CFP — 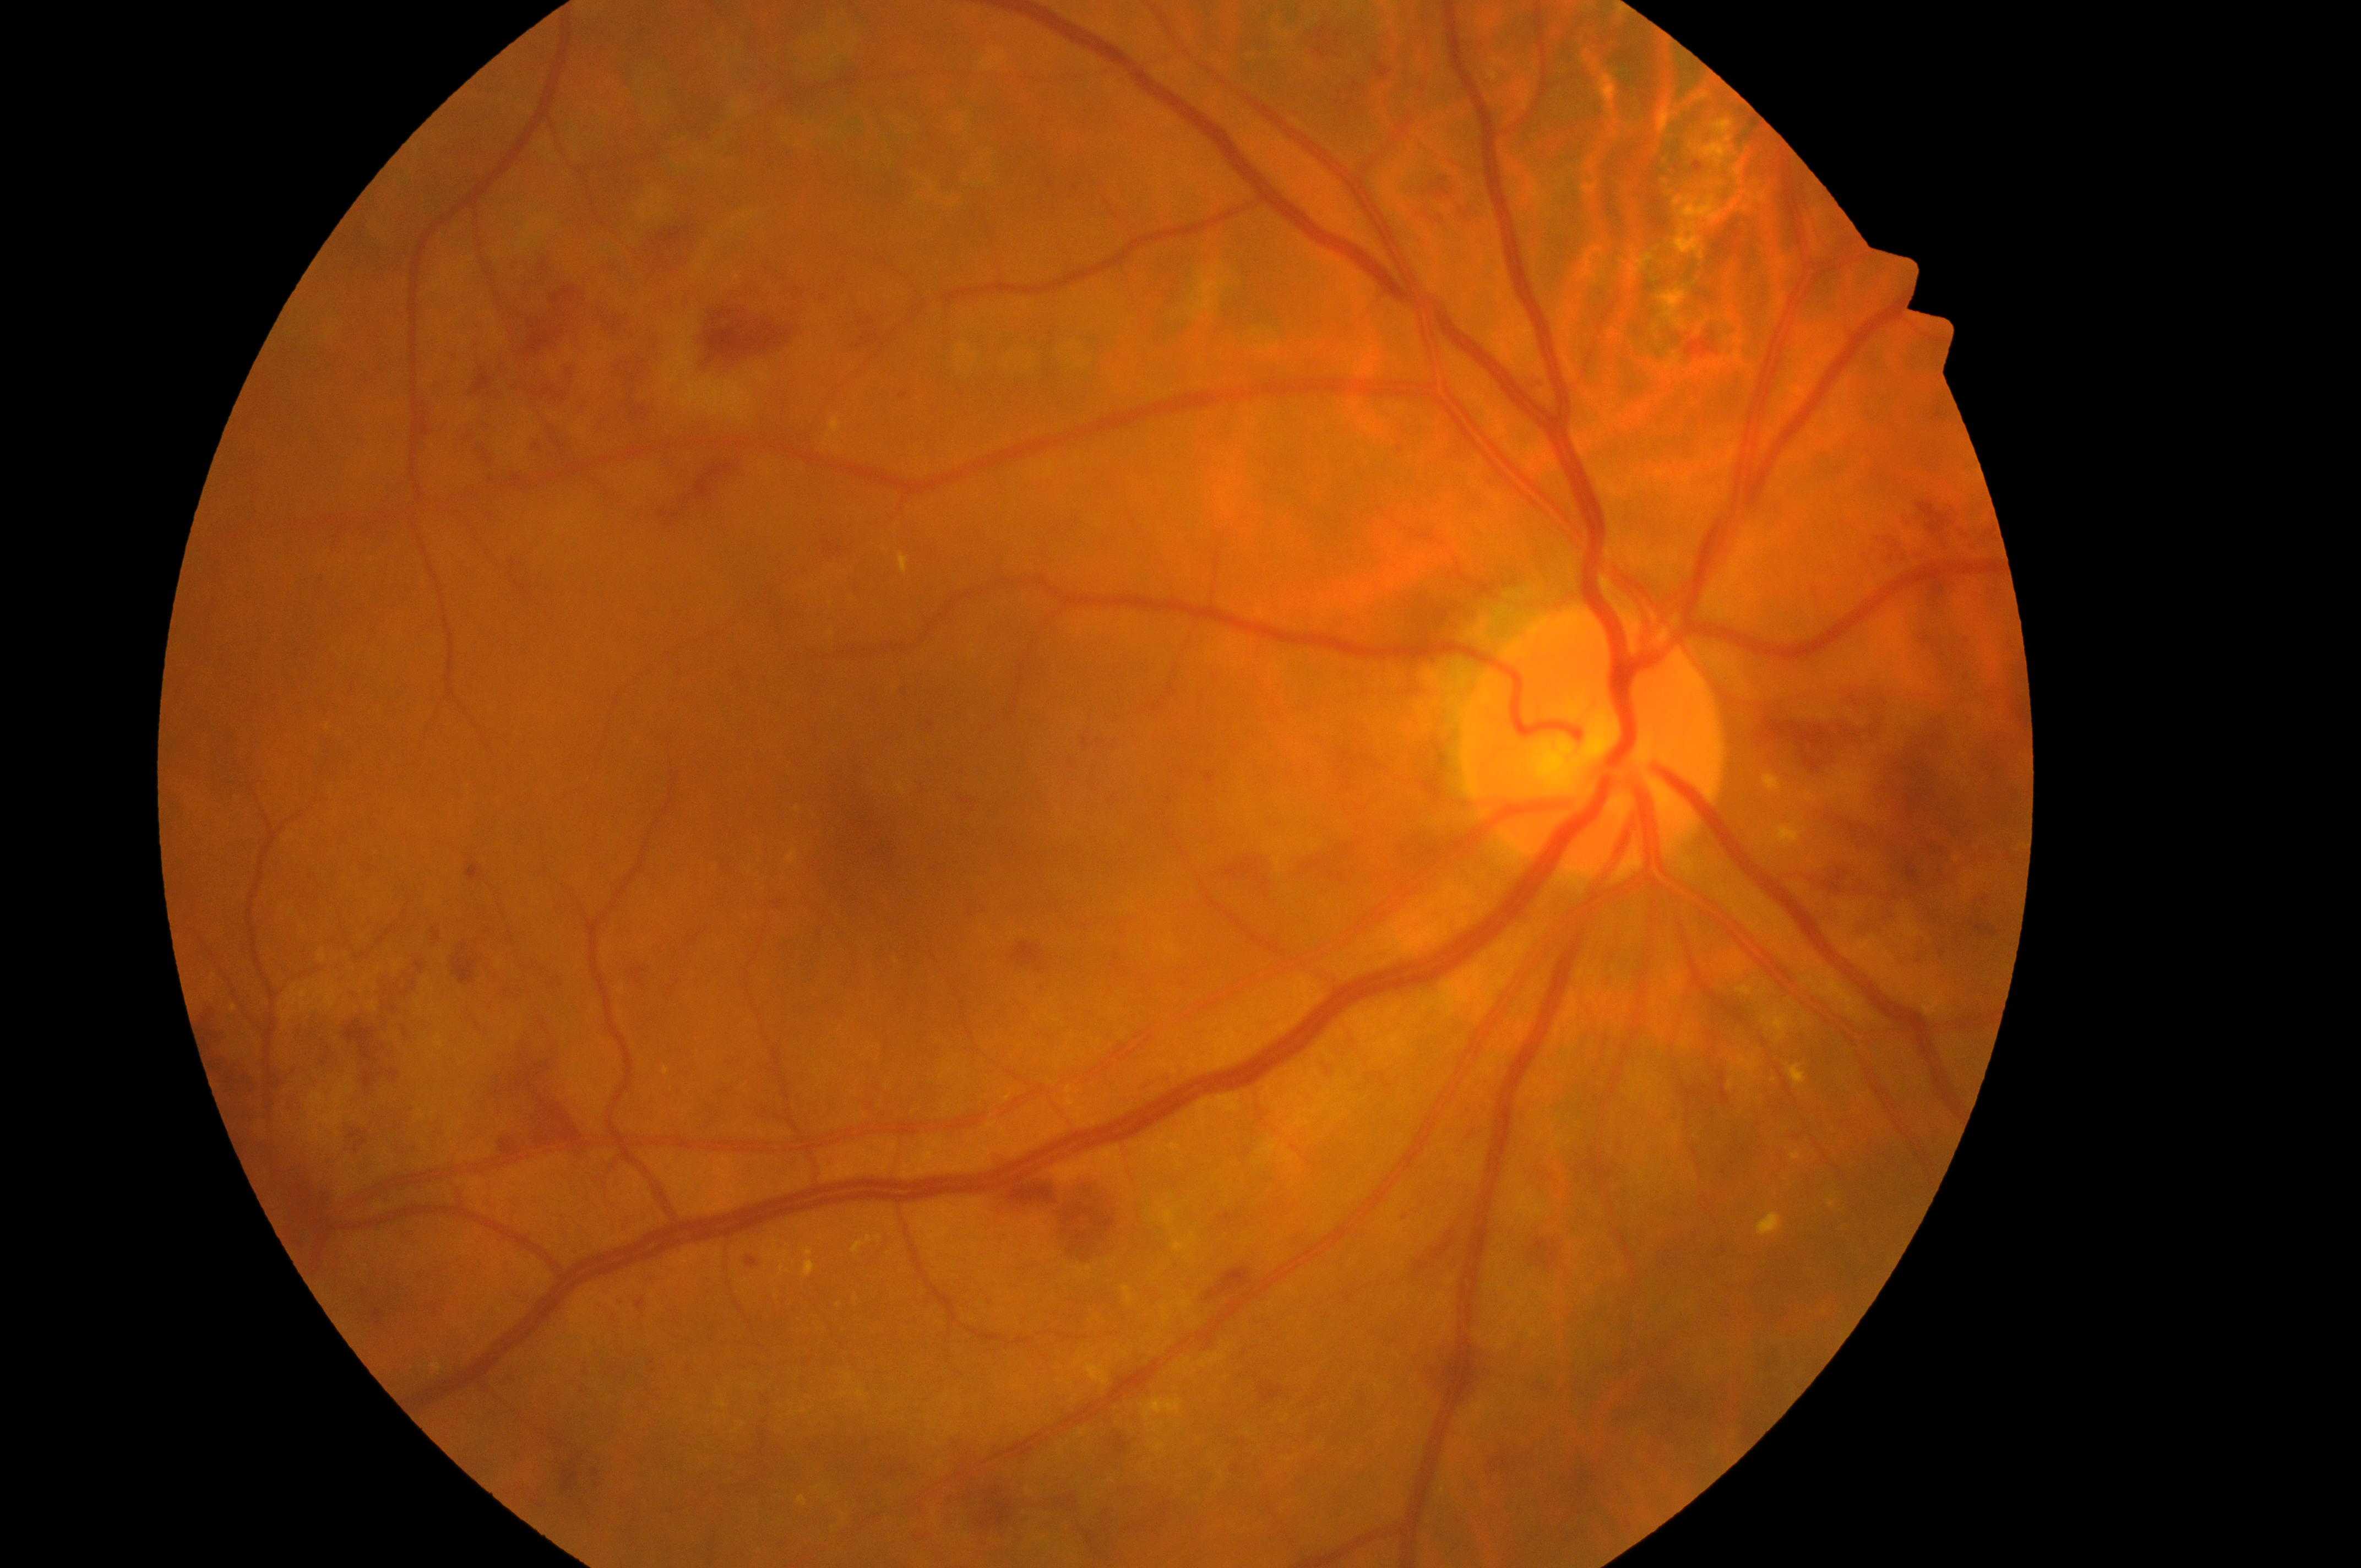
Annotations:
* DR class — non-proliferative diabetic retinopathy
* the fovea — (874,841)
* optic nerve head — (1592,752)
* eye — OD
* macular edema risk — grade 2 (high risk)
* retinopathy grade — severe non-proliferative diabetic retinopathy (3)